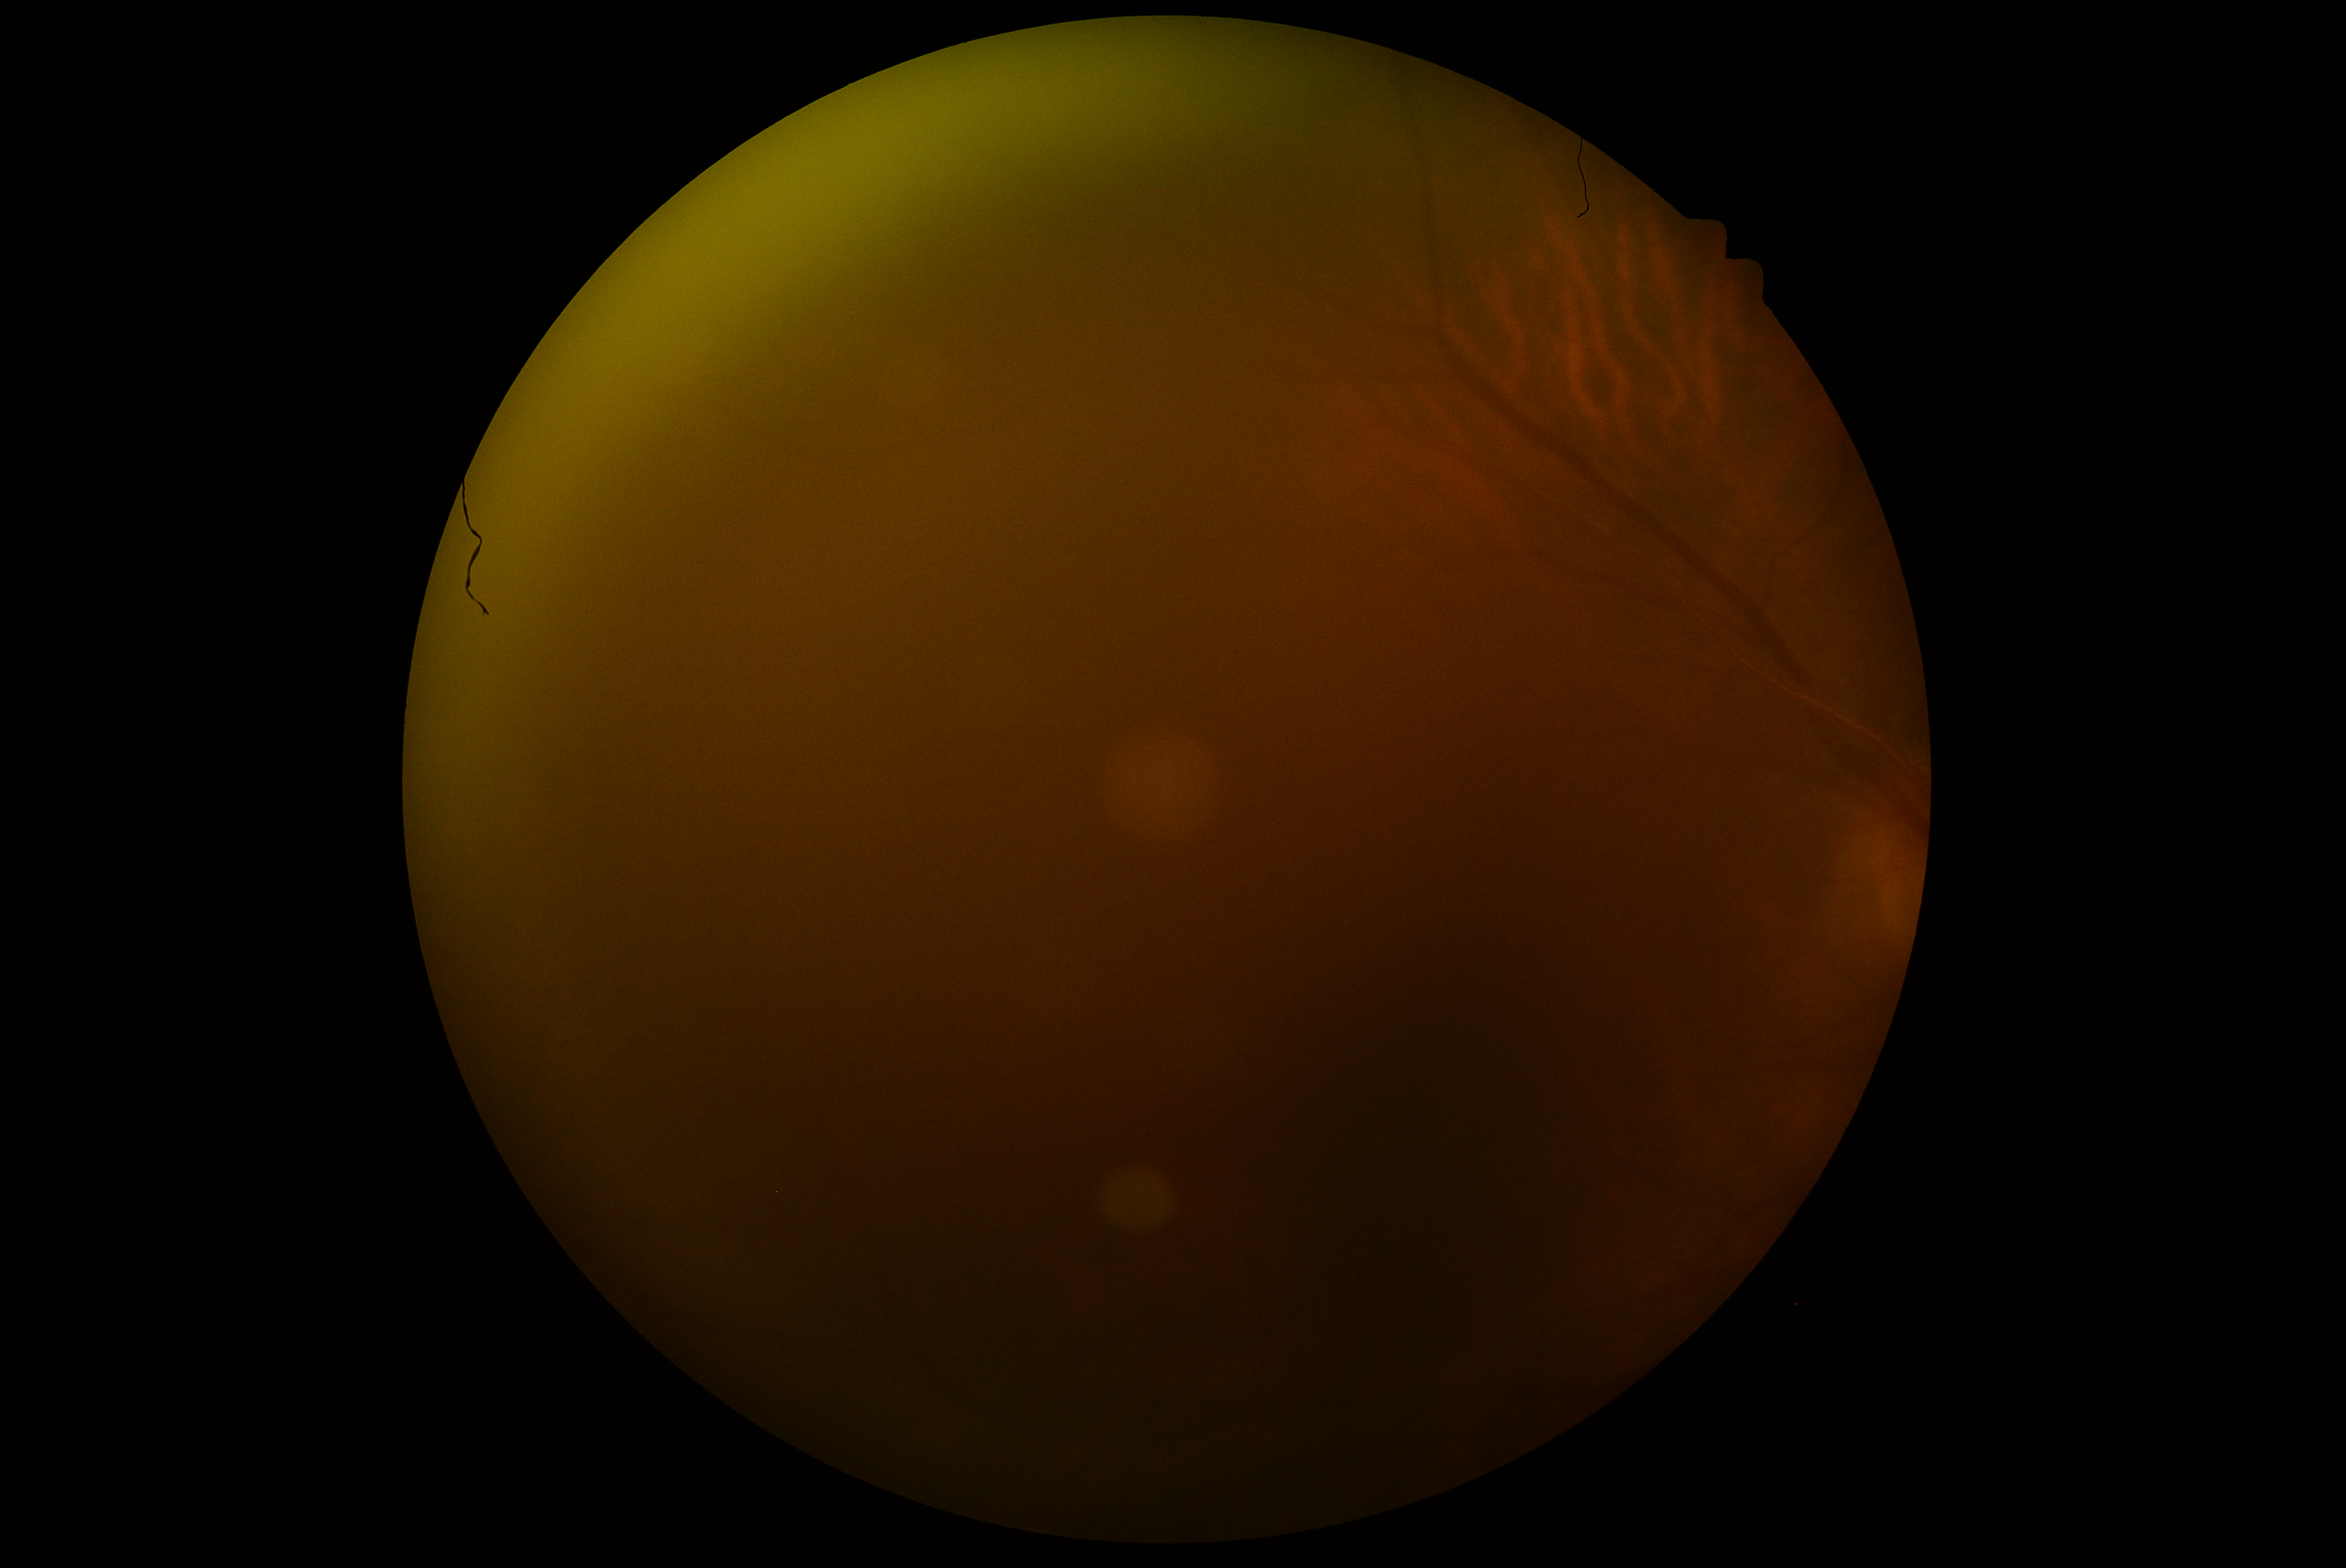
retinopathy grade: ungradable due to poor image quality
image quality: too poor for DR grading